No pharmacologic dilation; FOV: 45 degrees; color fundus photograph; DR severity per modified Davis staging
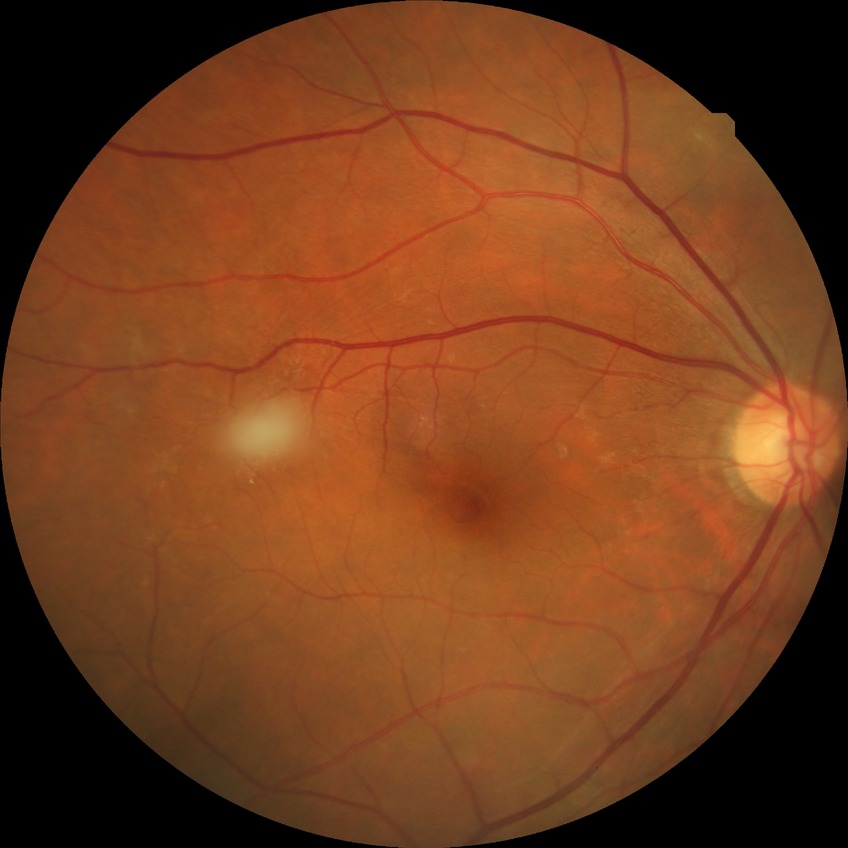
Retinopathy grade: no diabetic retinopathy.